240 by 240 pixels, non-mydriatic — 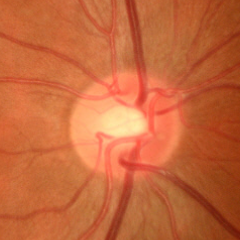 Findings consistent with early glaucoma.